Modified Davis grading
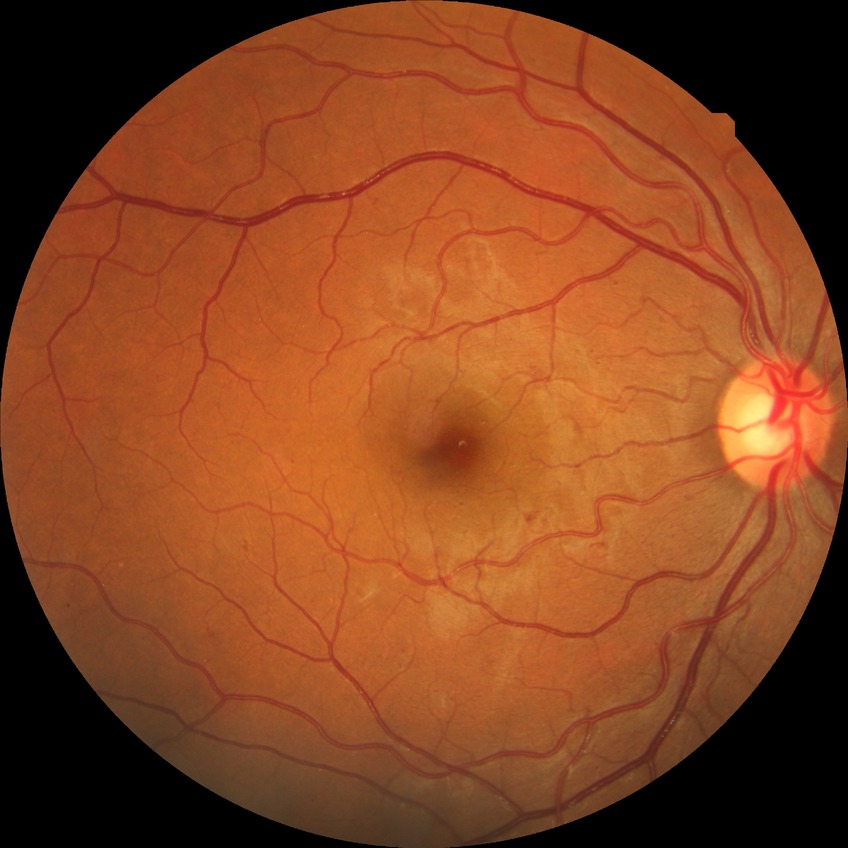

diabetic retinopathy (DR)@SDR (simple diabetic retinopathy).